Color fundus photograph
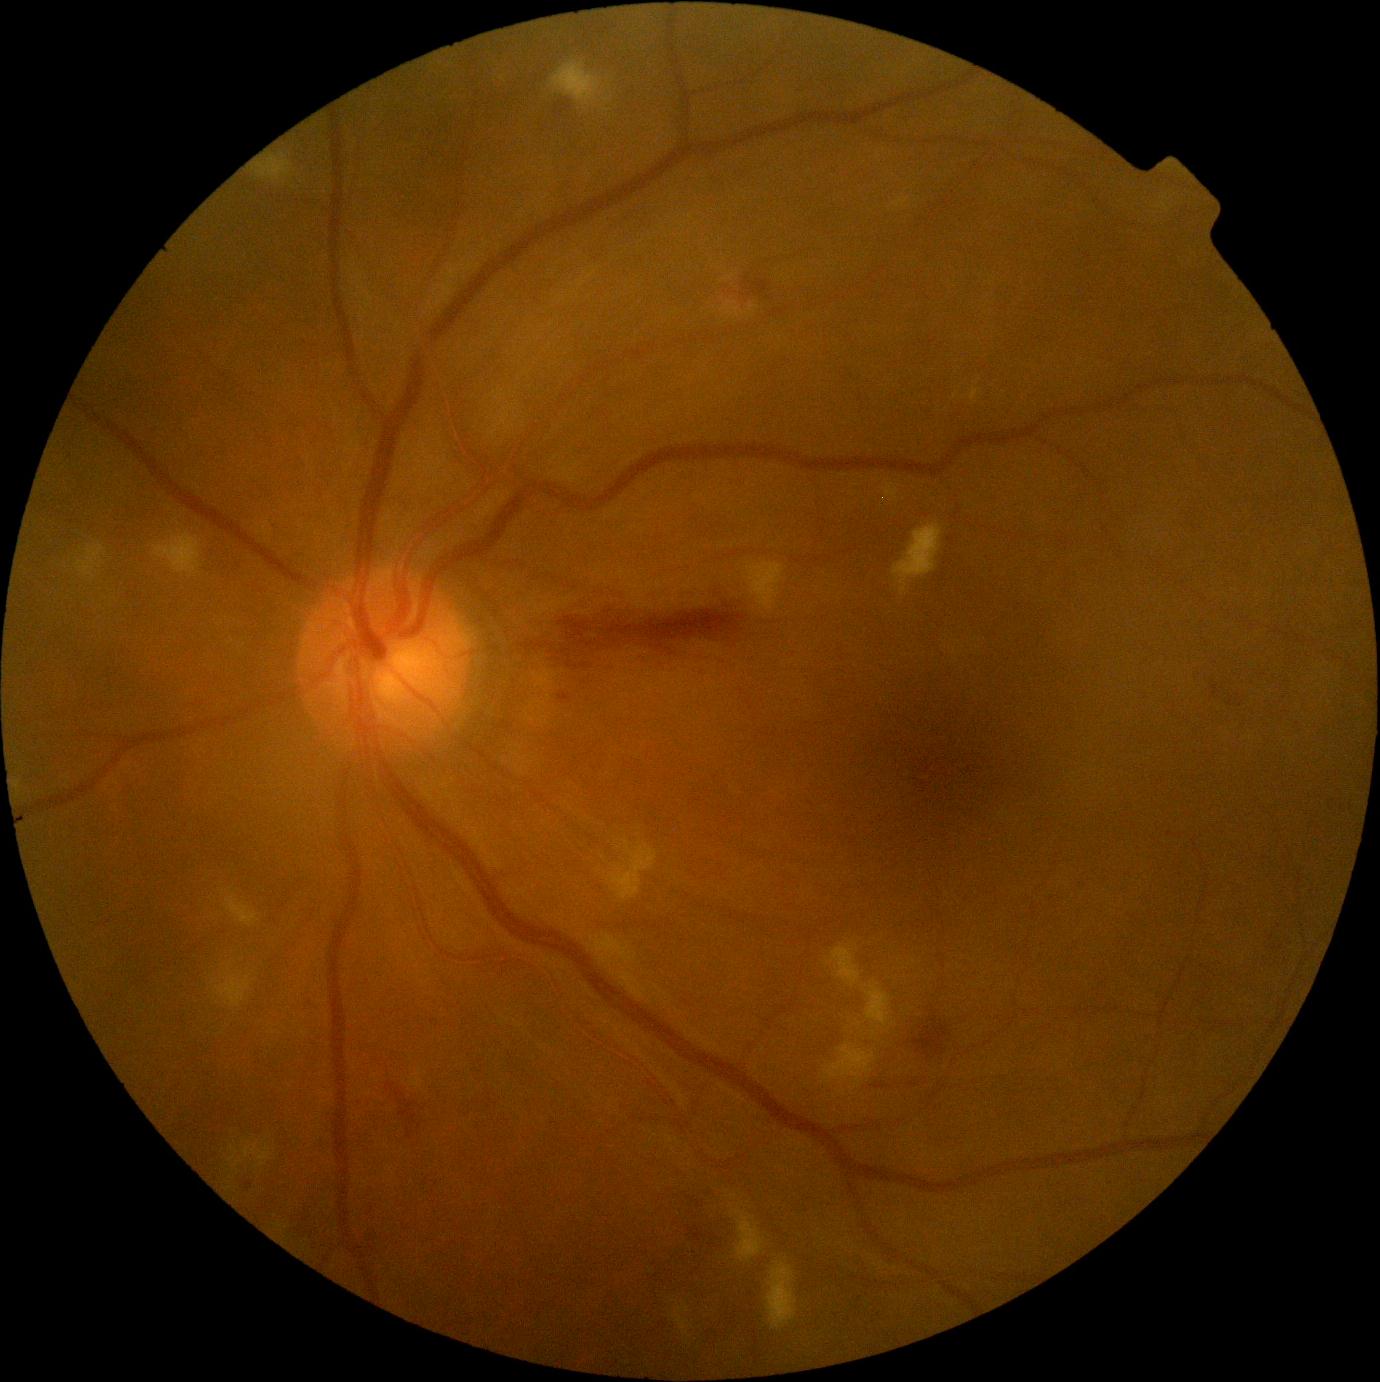

{
  "dr_category": "non-proliferative diabetic retinopathy",
  "dr_grade": "2 (moderate NPDR)"
}